Modified Davis grading: 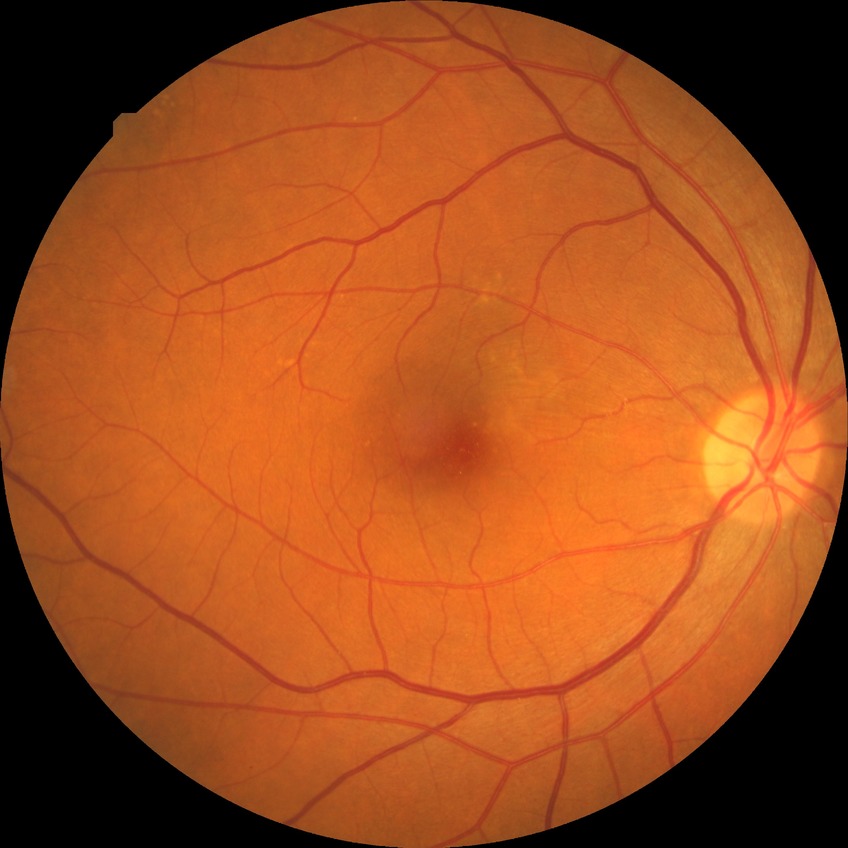 Diabetic retinopathy grade: no diabetic retinopathy.